Modified Davis grading — 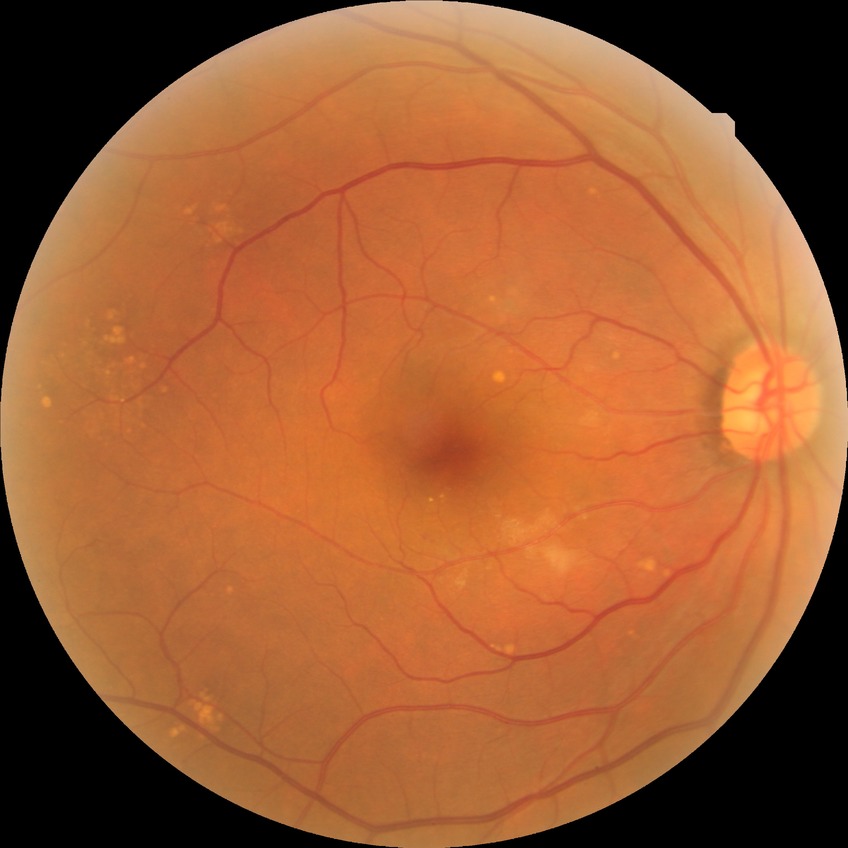
Diabetic retinopathy (DR): no diabetic retinopathy (NDR).